Fundus photo: 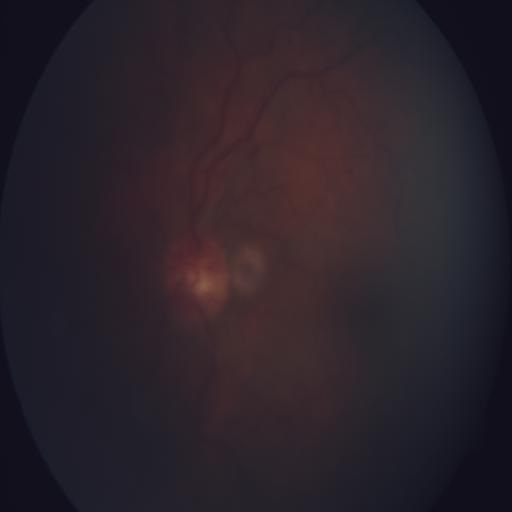

Diagnosis: media haze.